Without pupil dilation: 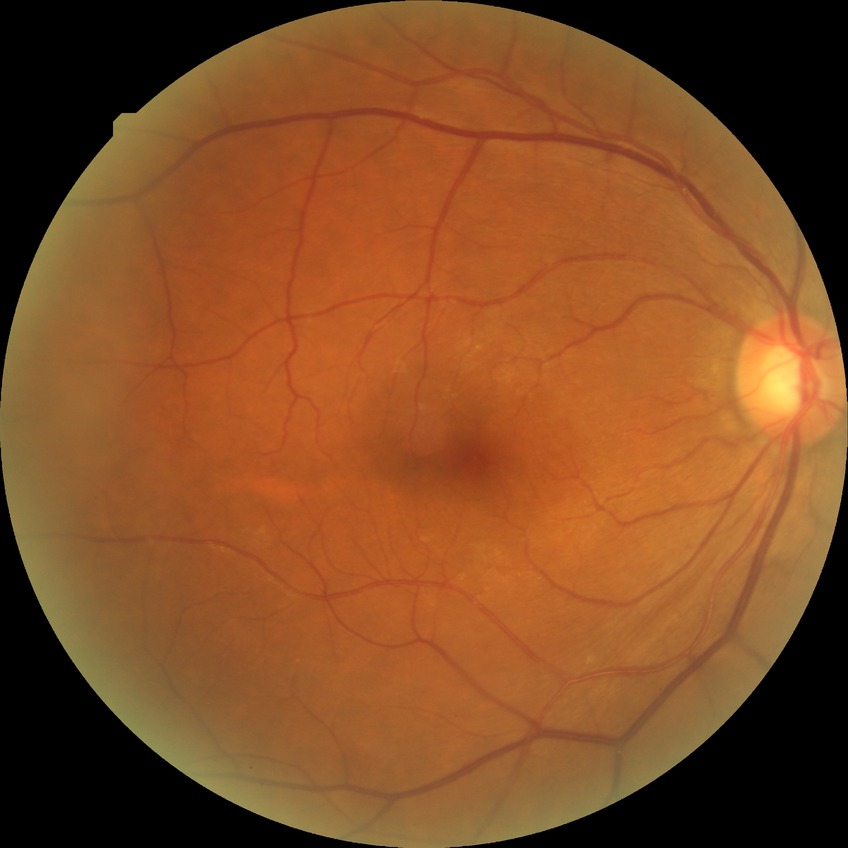 {
  "davis_grade": "no diabetic retinopathy"
}